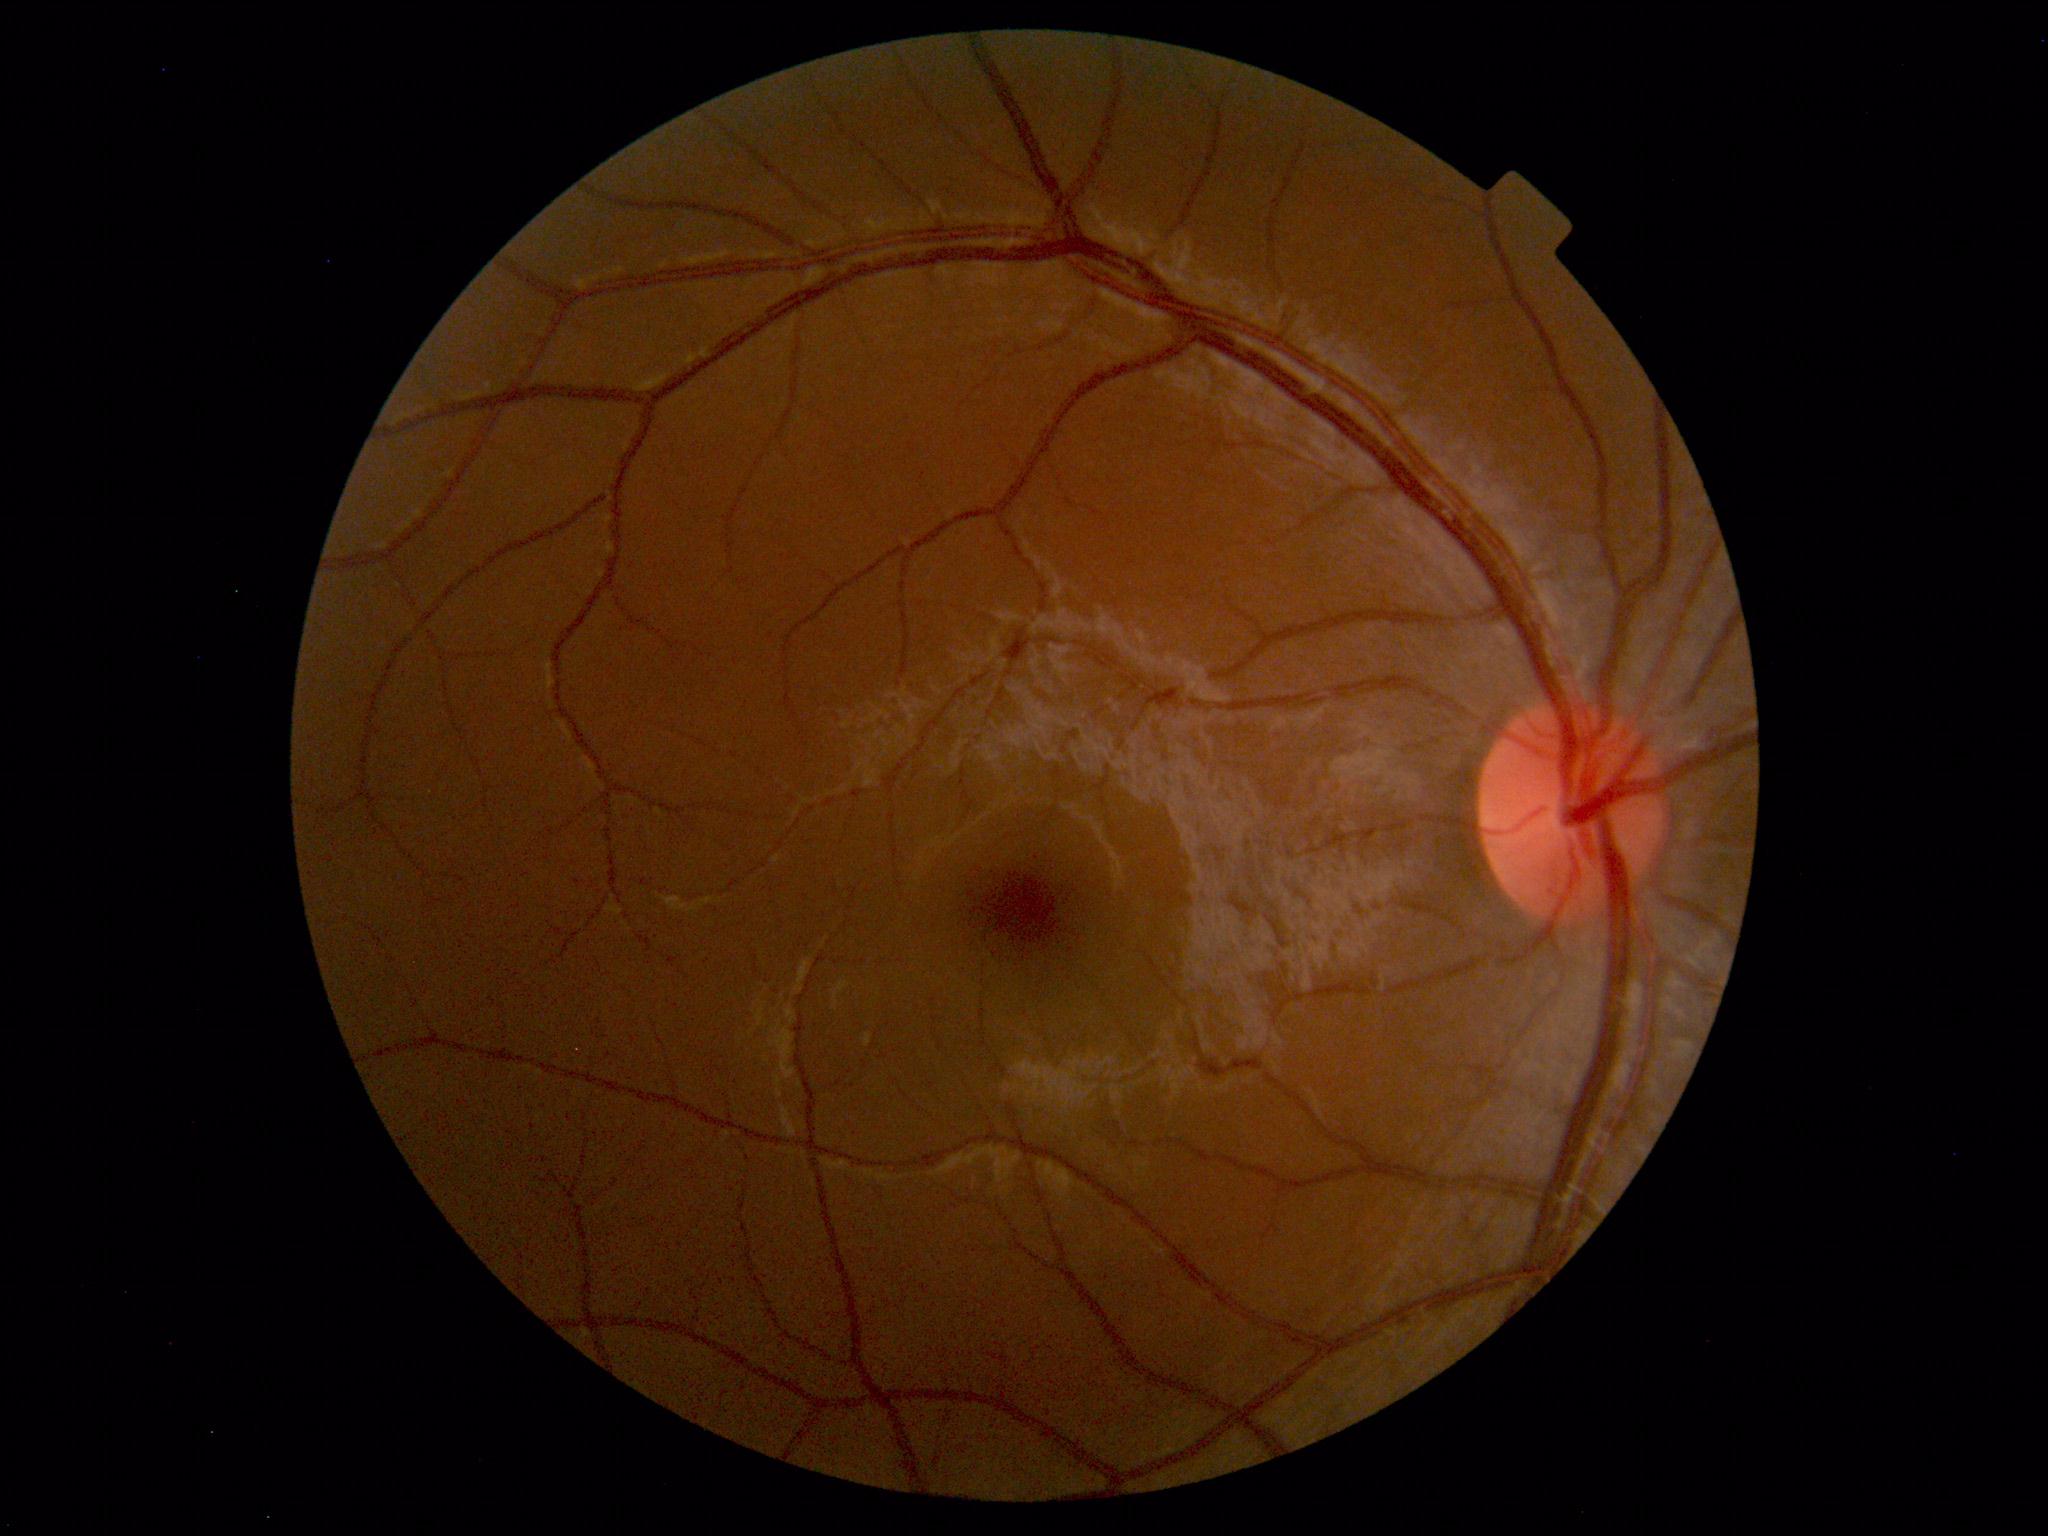

Findings: none. Normal fundus.